Wide-field fundus photograph of an infant: 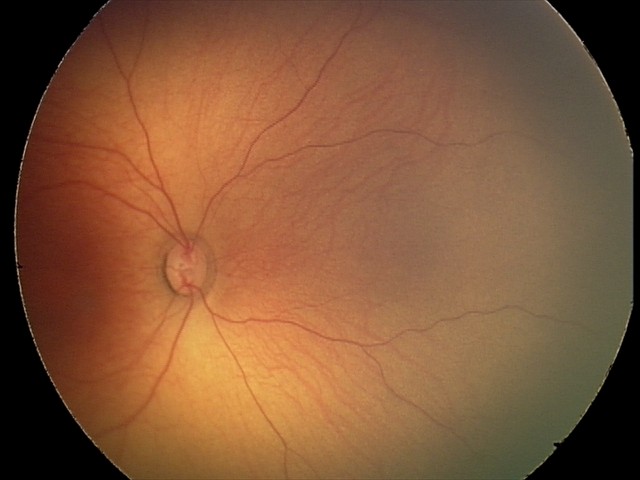
Physiological retinal appearance for postconceptual age.